848 x 848 pixels: 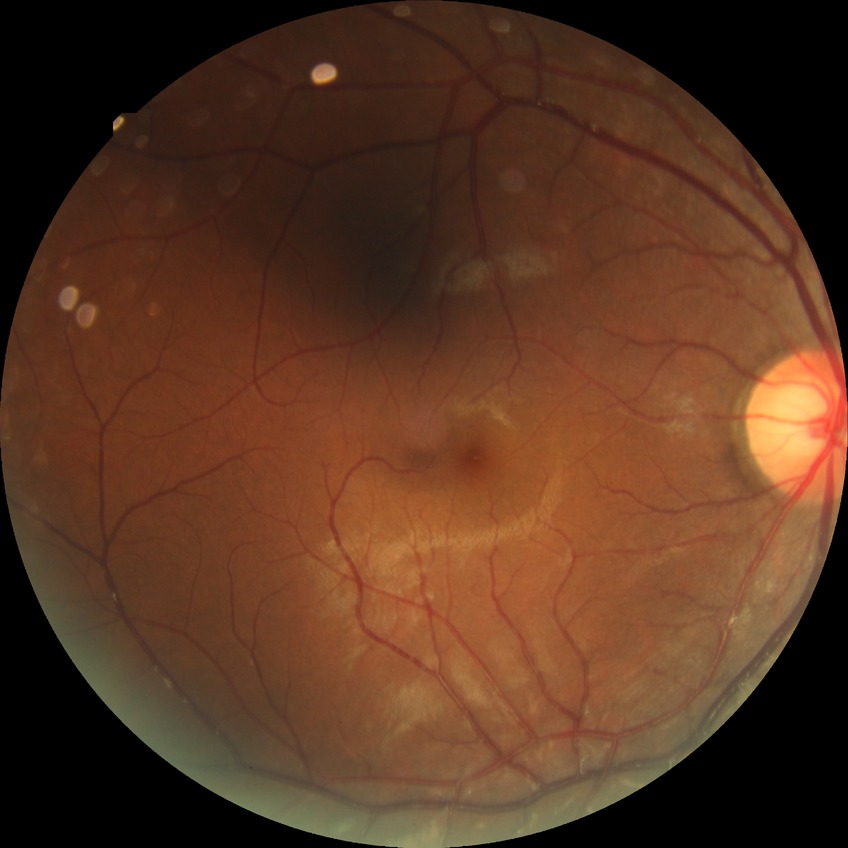
modified Davis grading=no diabetic retinopathy.